2102 by 1736 pixels — 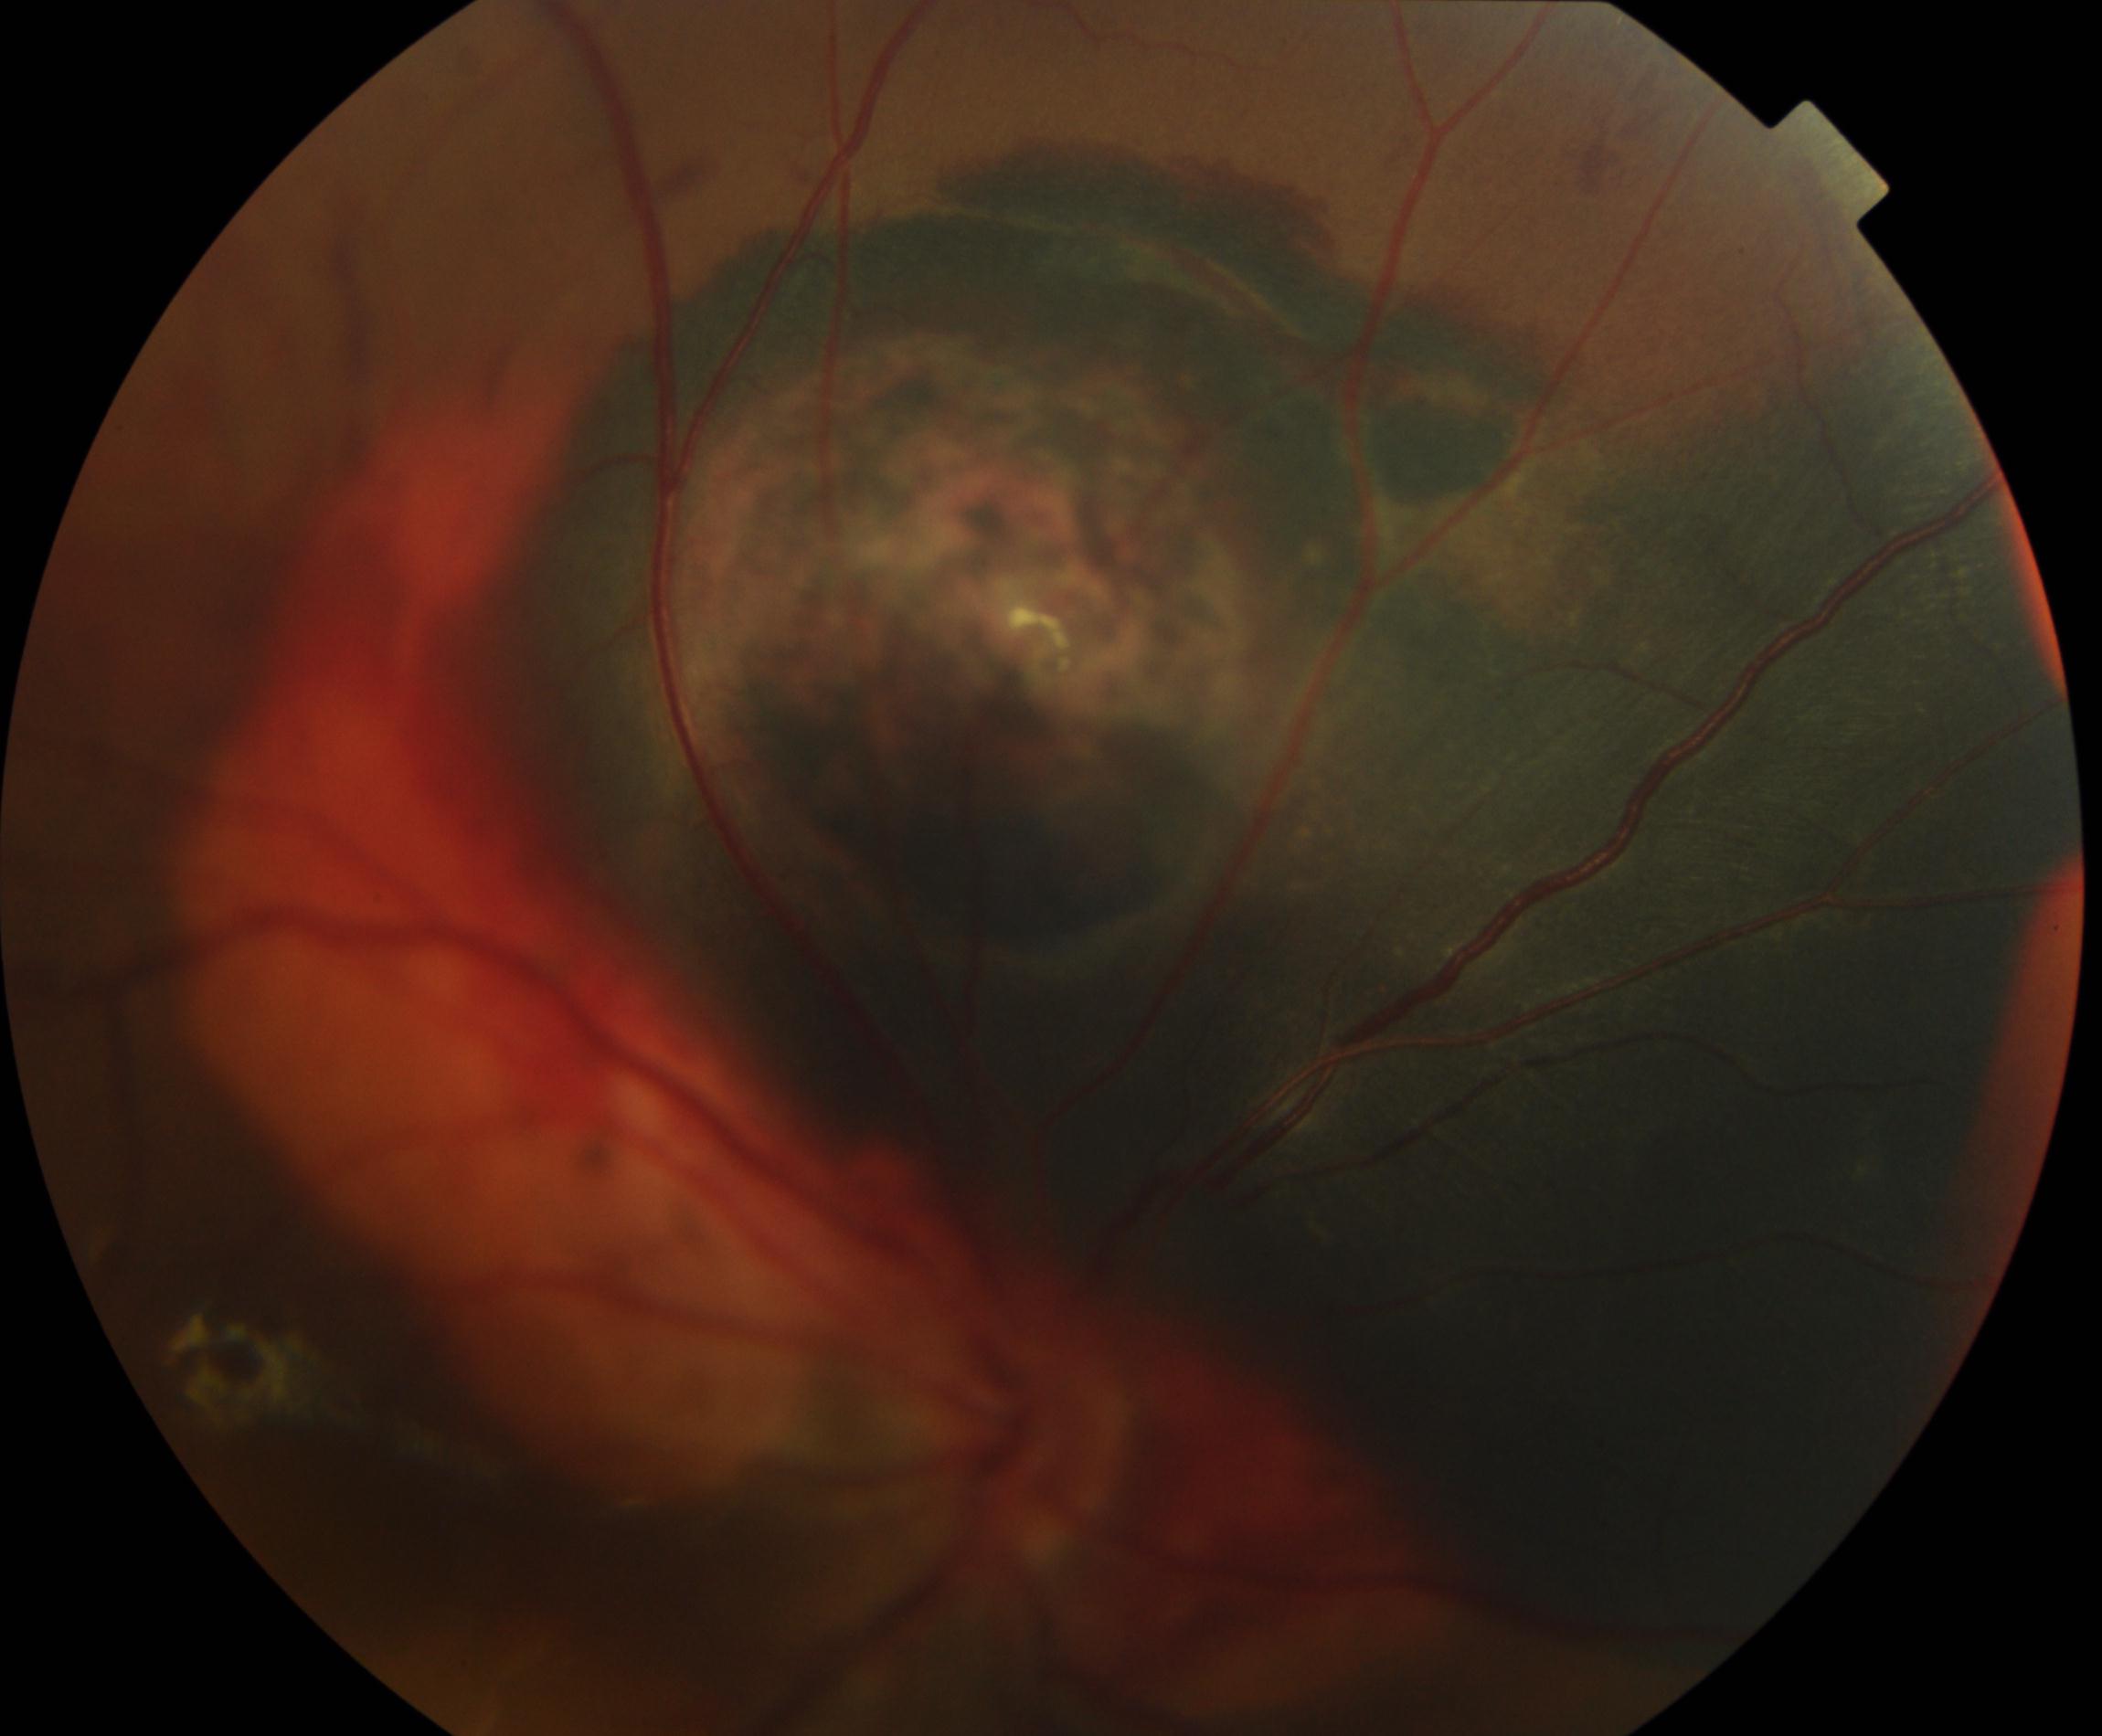 Retinal fundus photograph demonstrating fundus neoplasm.